Fundus photo · mydriatic (tropicamide 0.5%) · 50-degree field of view · macula-centered · camera: Kowa VX-10α:
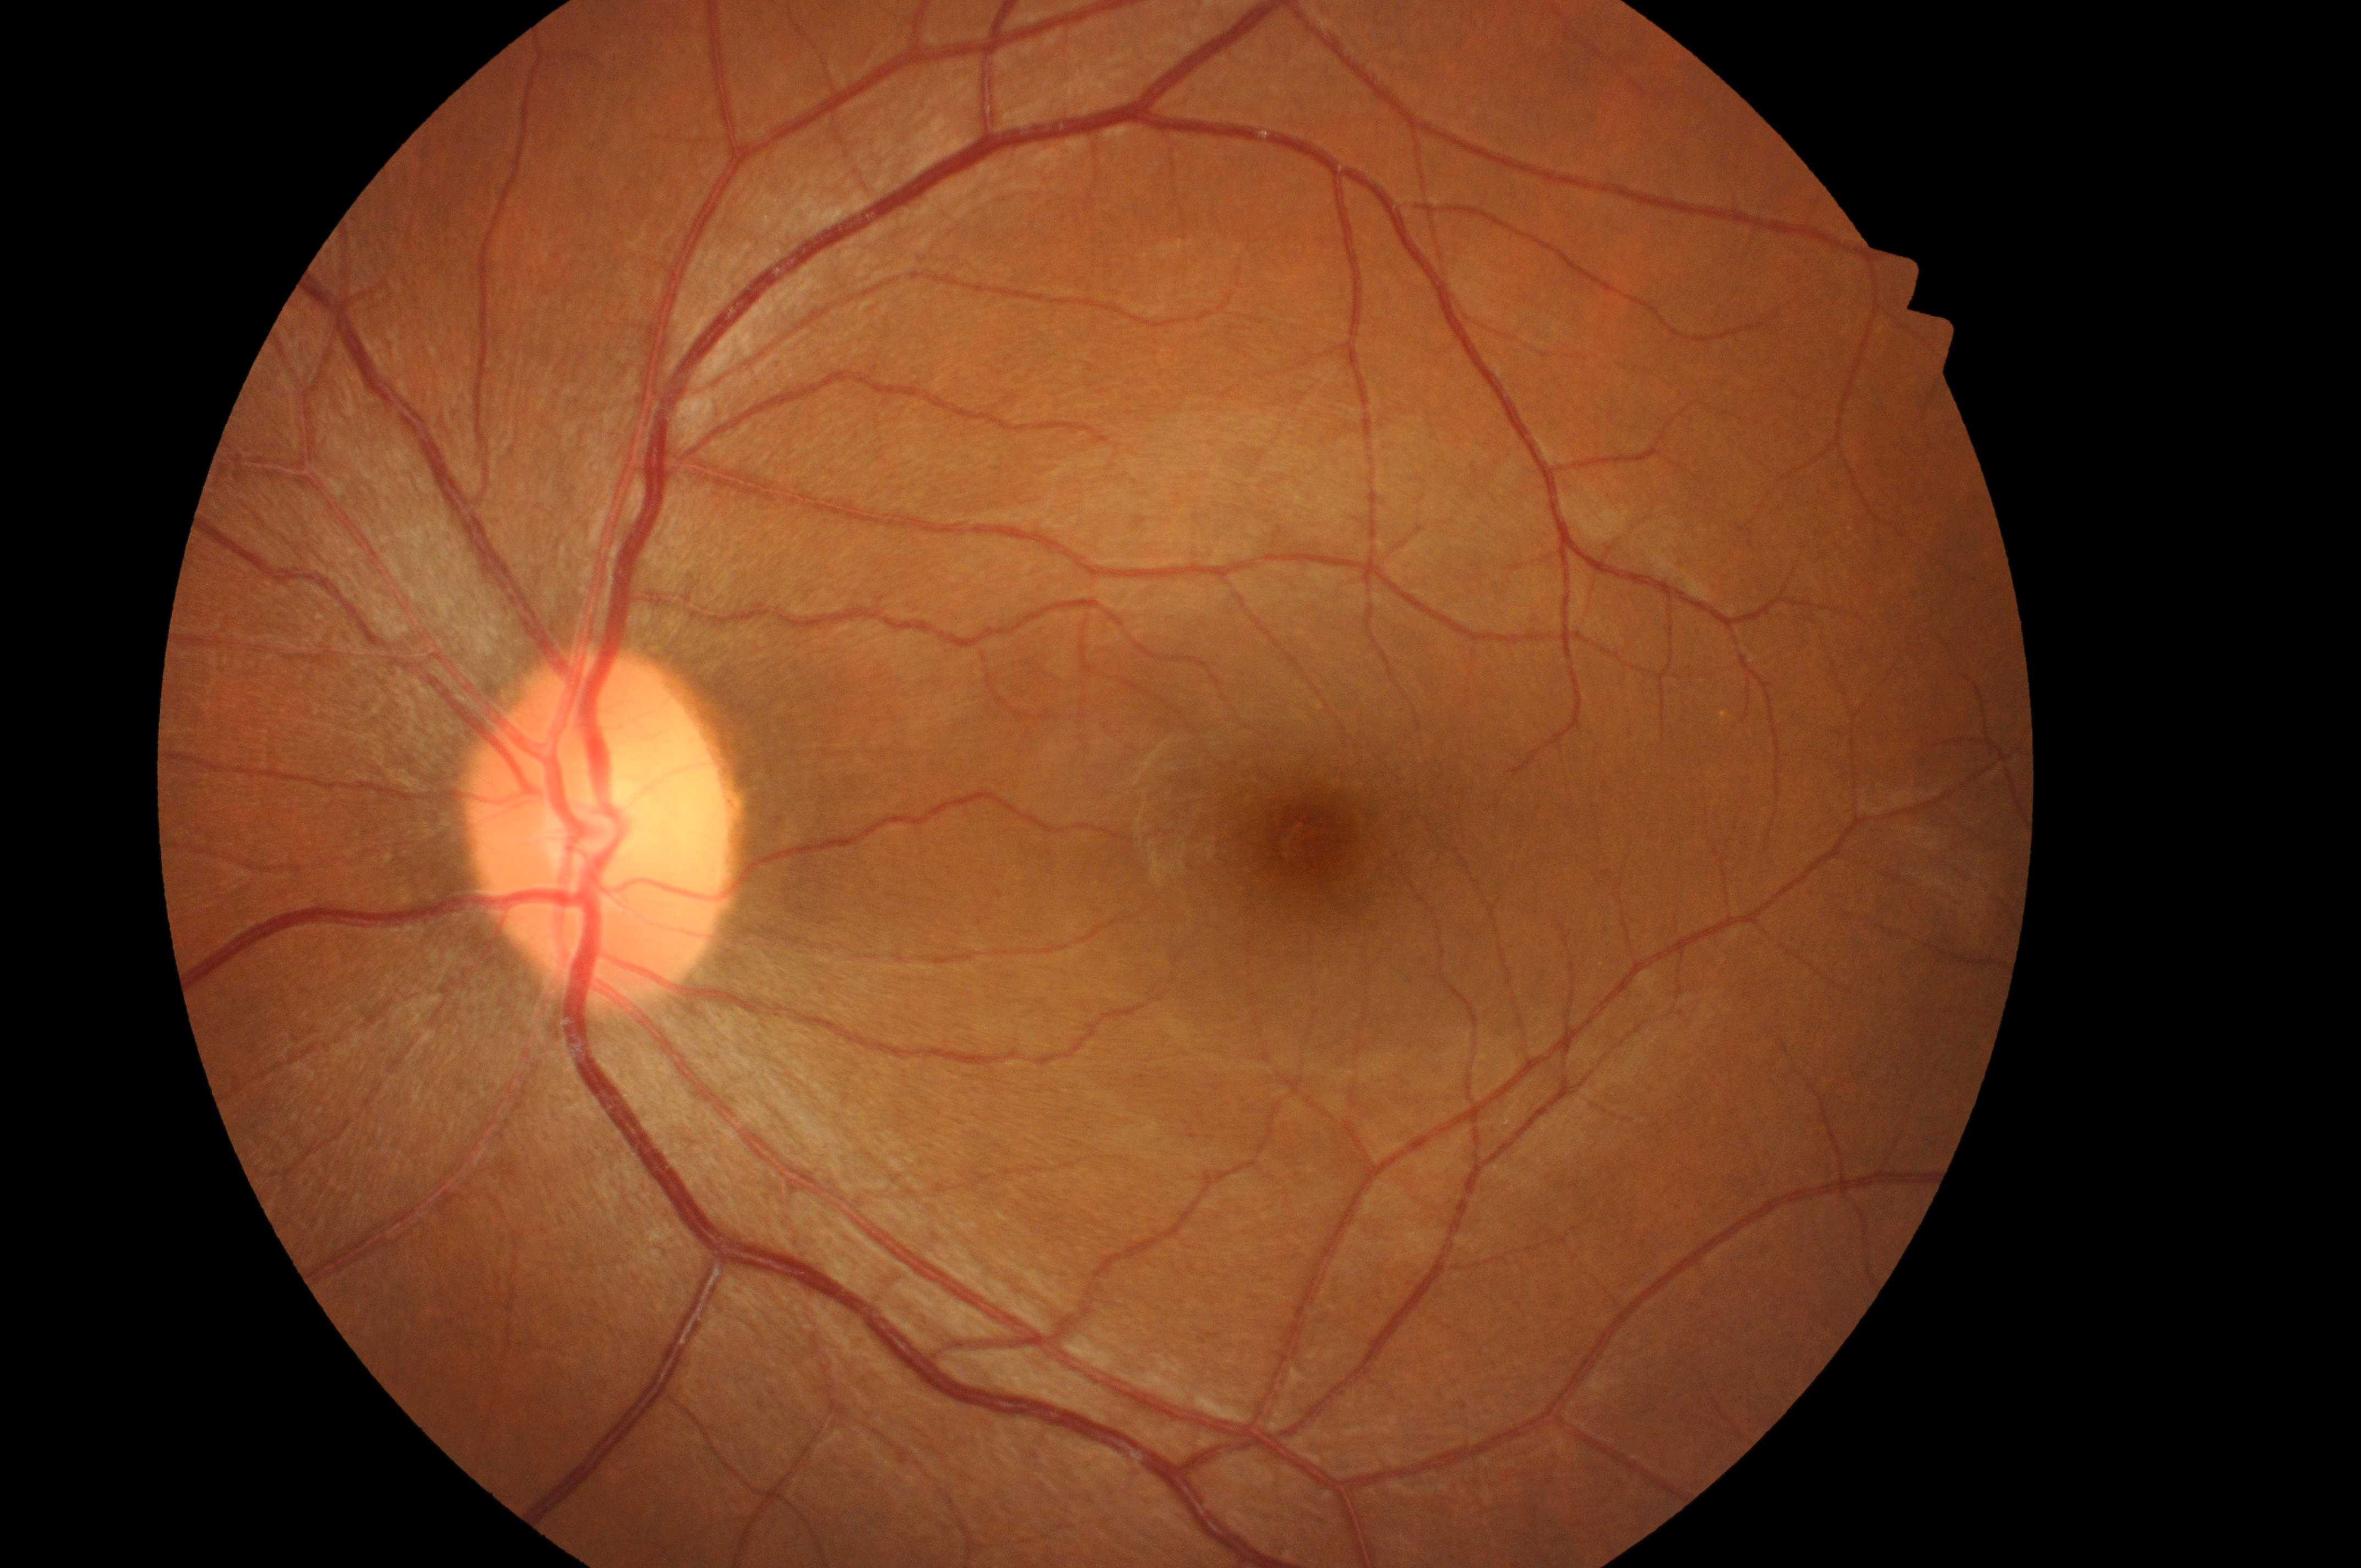 Q: Optic disc center?
A: (x: 600, y: 839)
Q: What is the DME risk grade?
A: grade 0 (no risk) — no apparent hard exudates
Q: Which eye is imaged?
A: oculus sinister
Q: What is the DR grade?
A: no apparent retinopathy (0) — no visible signs of diabetic retinopathy
Q: Locate the fovea.
A: (x: 1310, y: 843)
Q: Any diabetic retinopathy?
A: No DR or DME findings